Color fundus image · 2352 x 1568 pixels · 45° field of view:
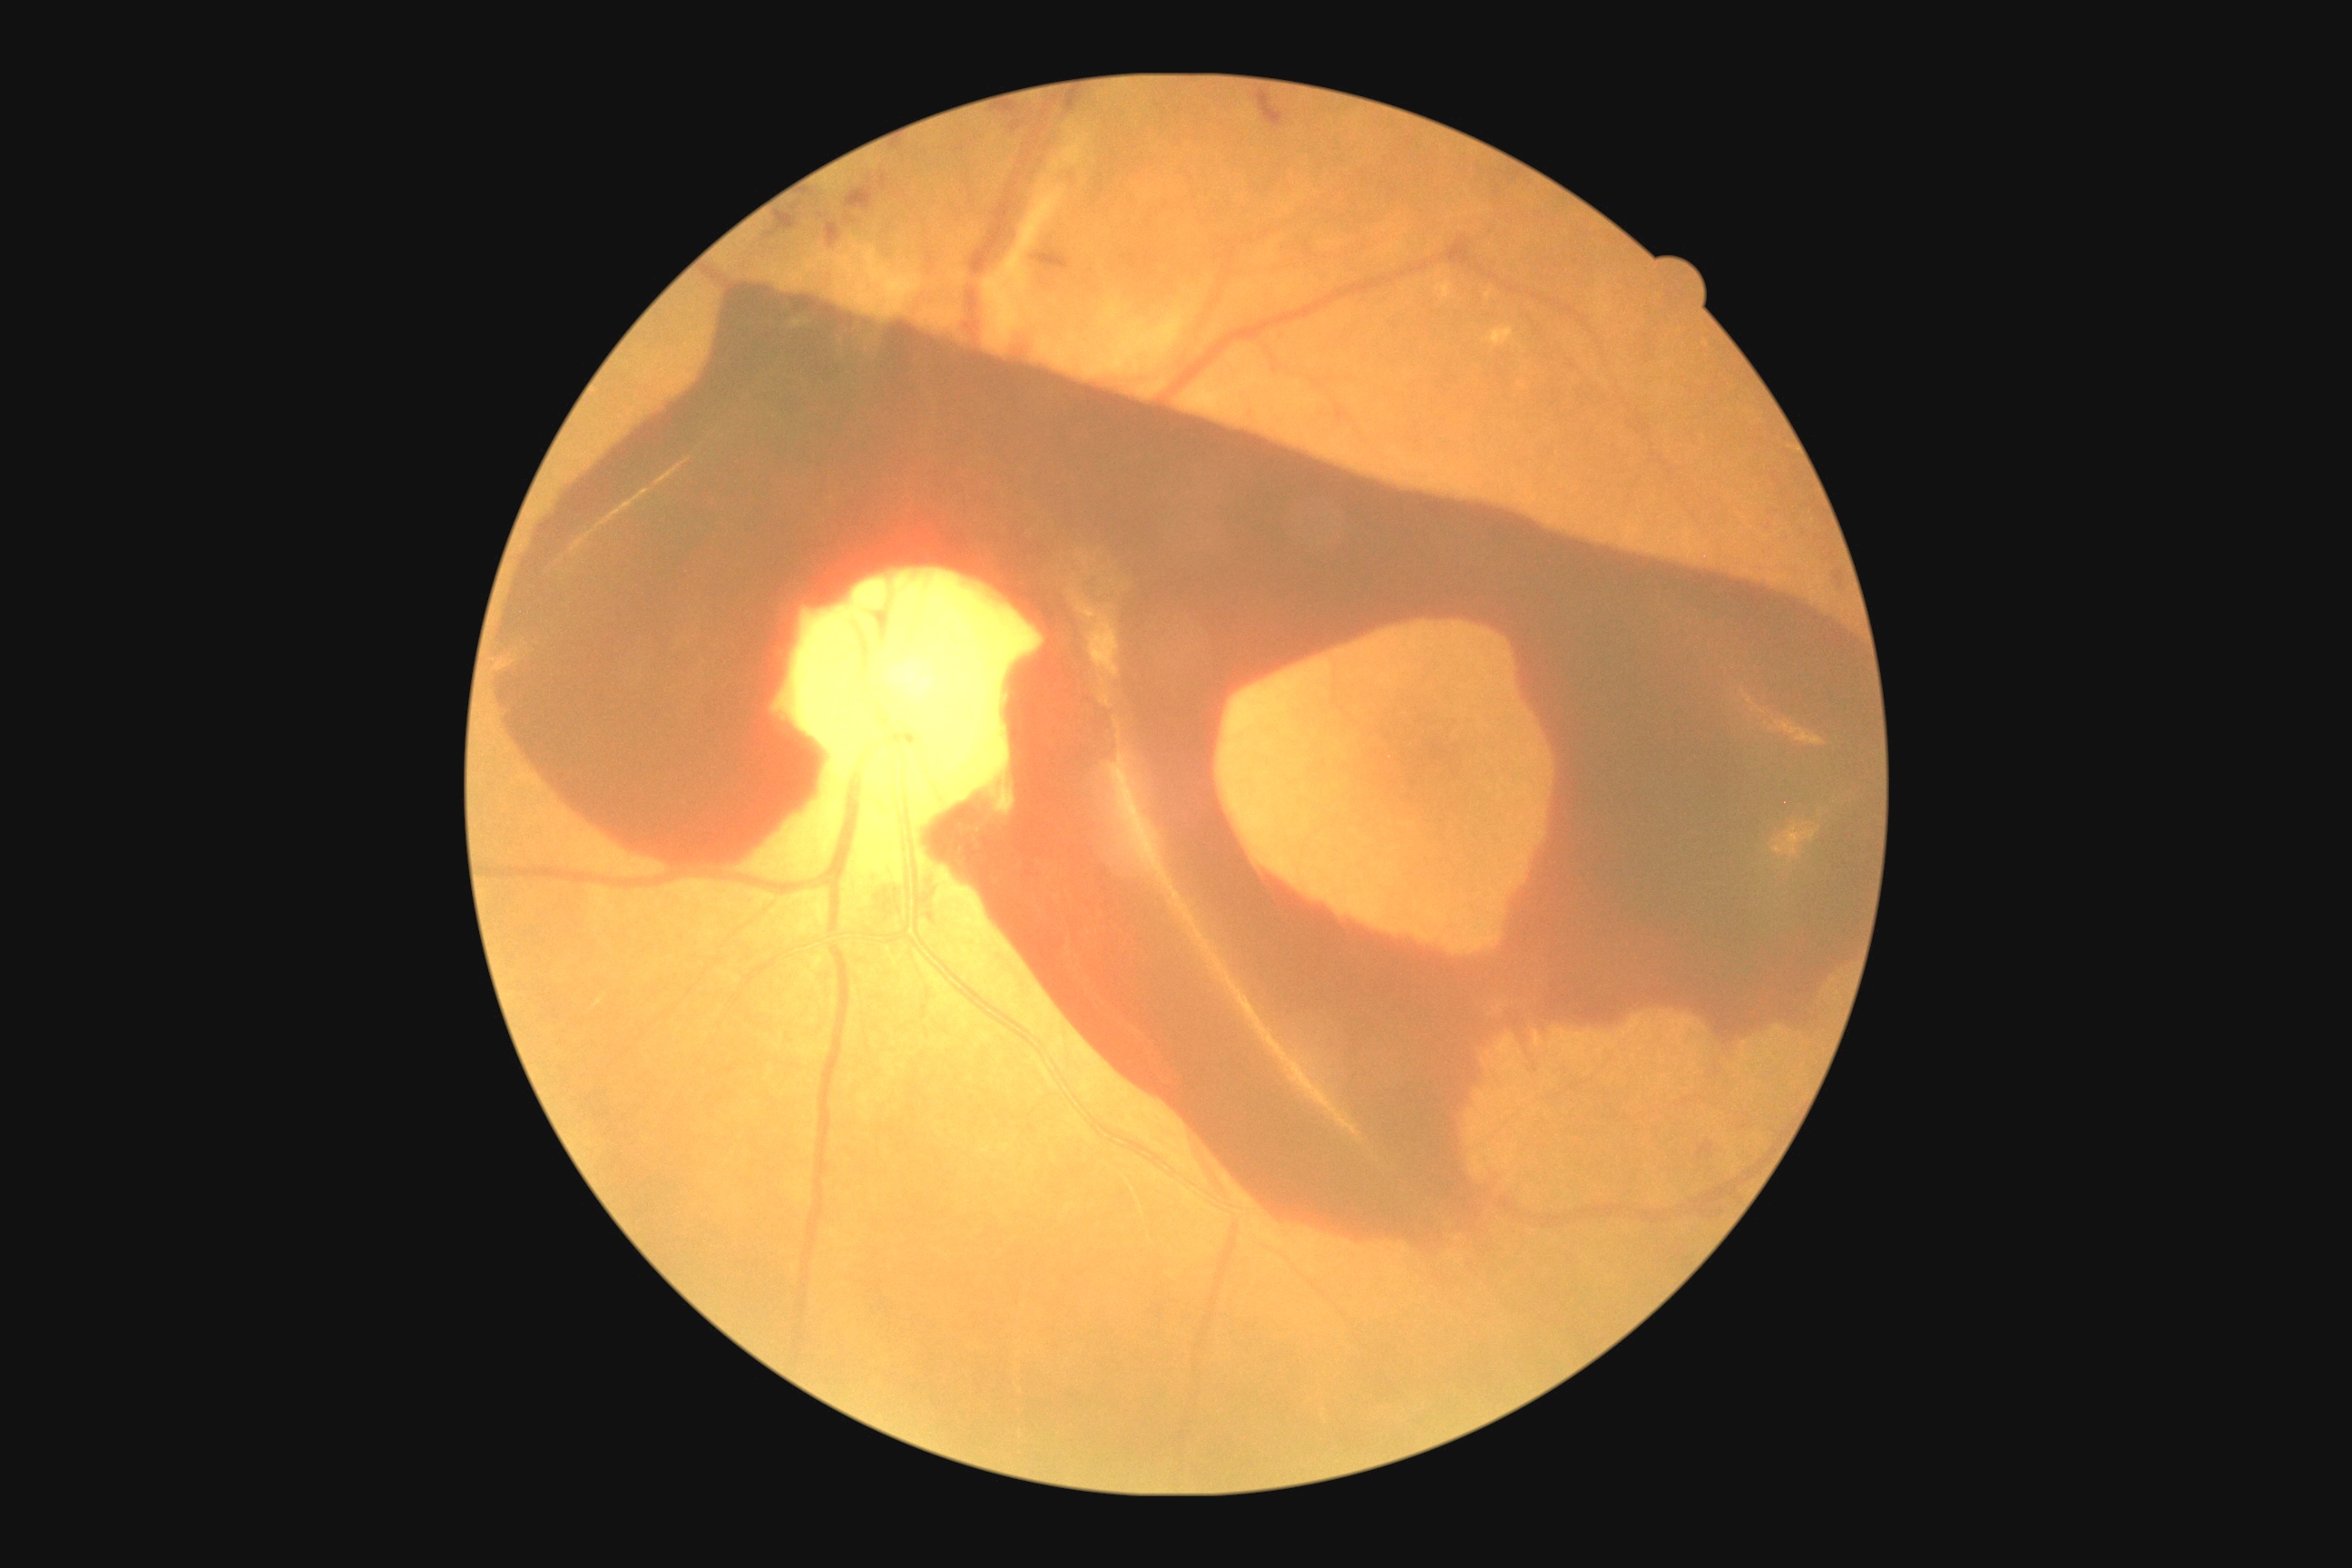
- DR — 4